FOV: 45 degrees, image size 2352x1568
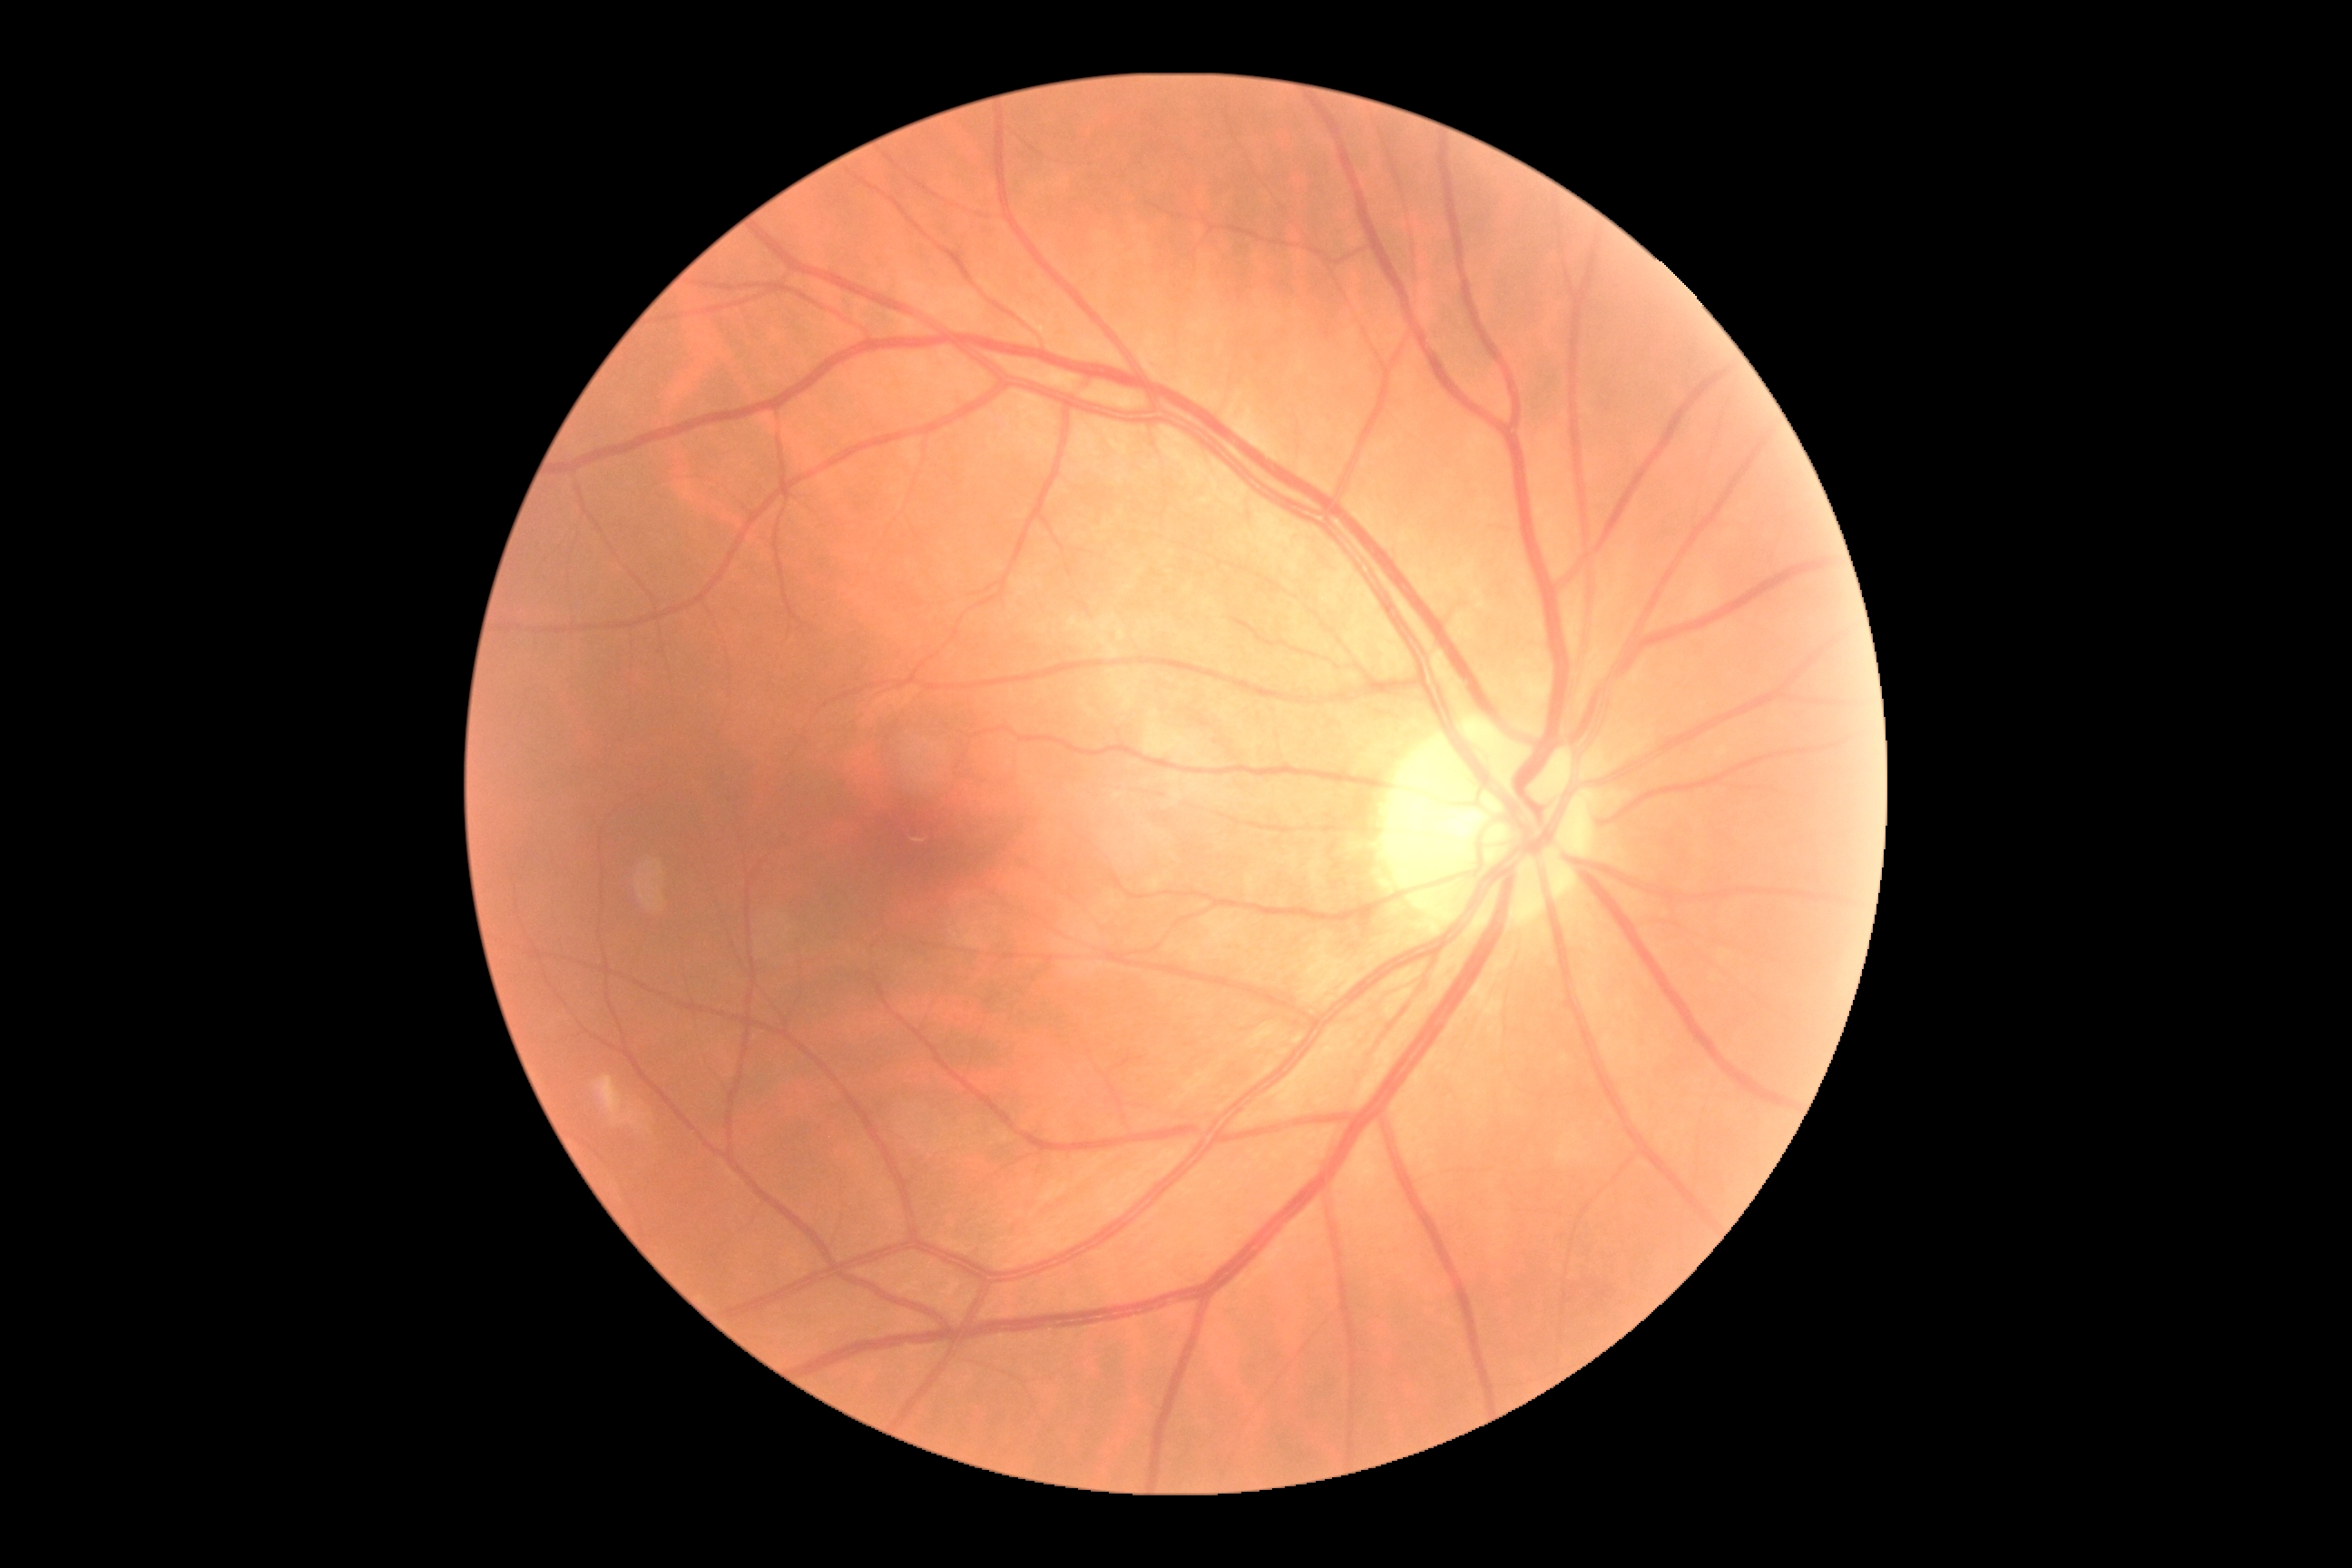

DR stage is no apparent diabetic retinopathy (grade 0).